45-degree field of view.
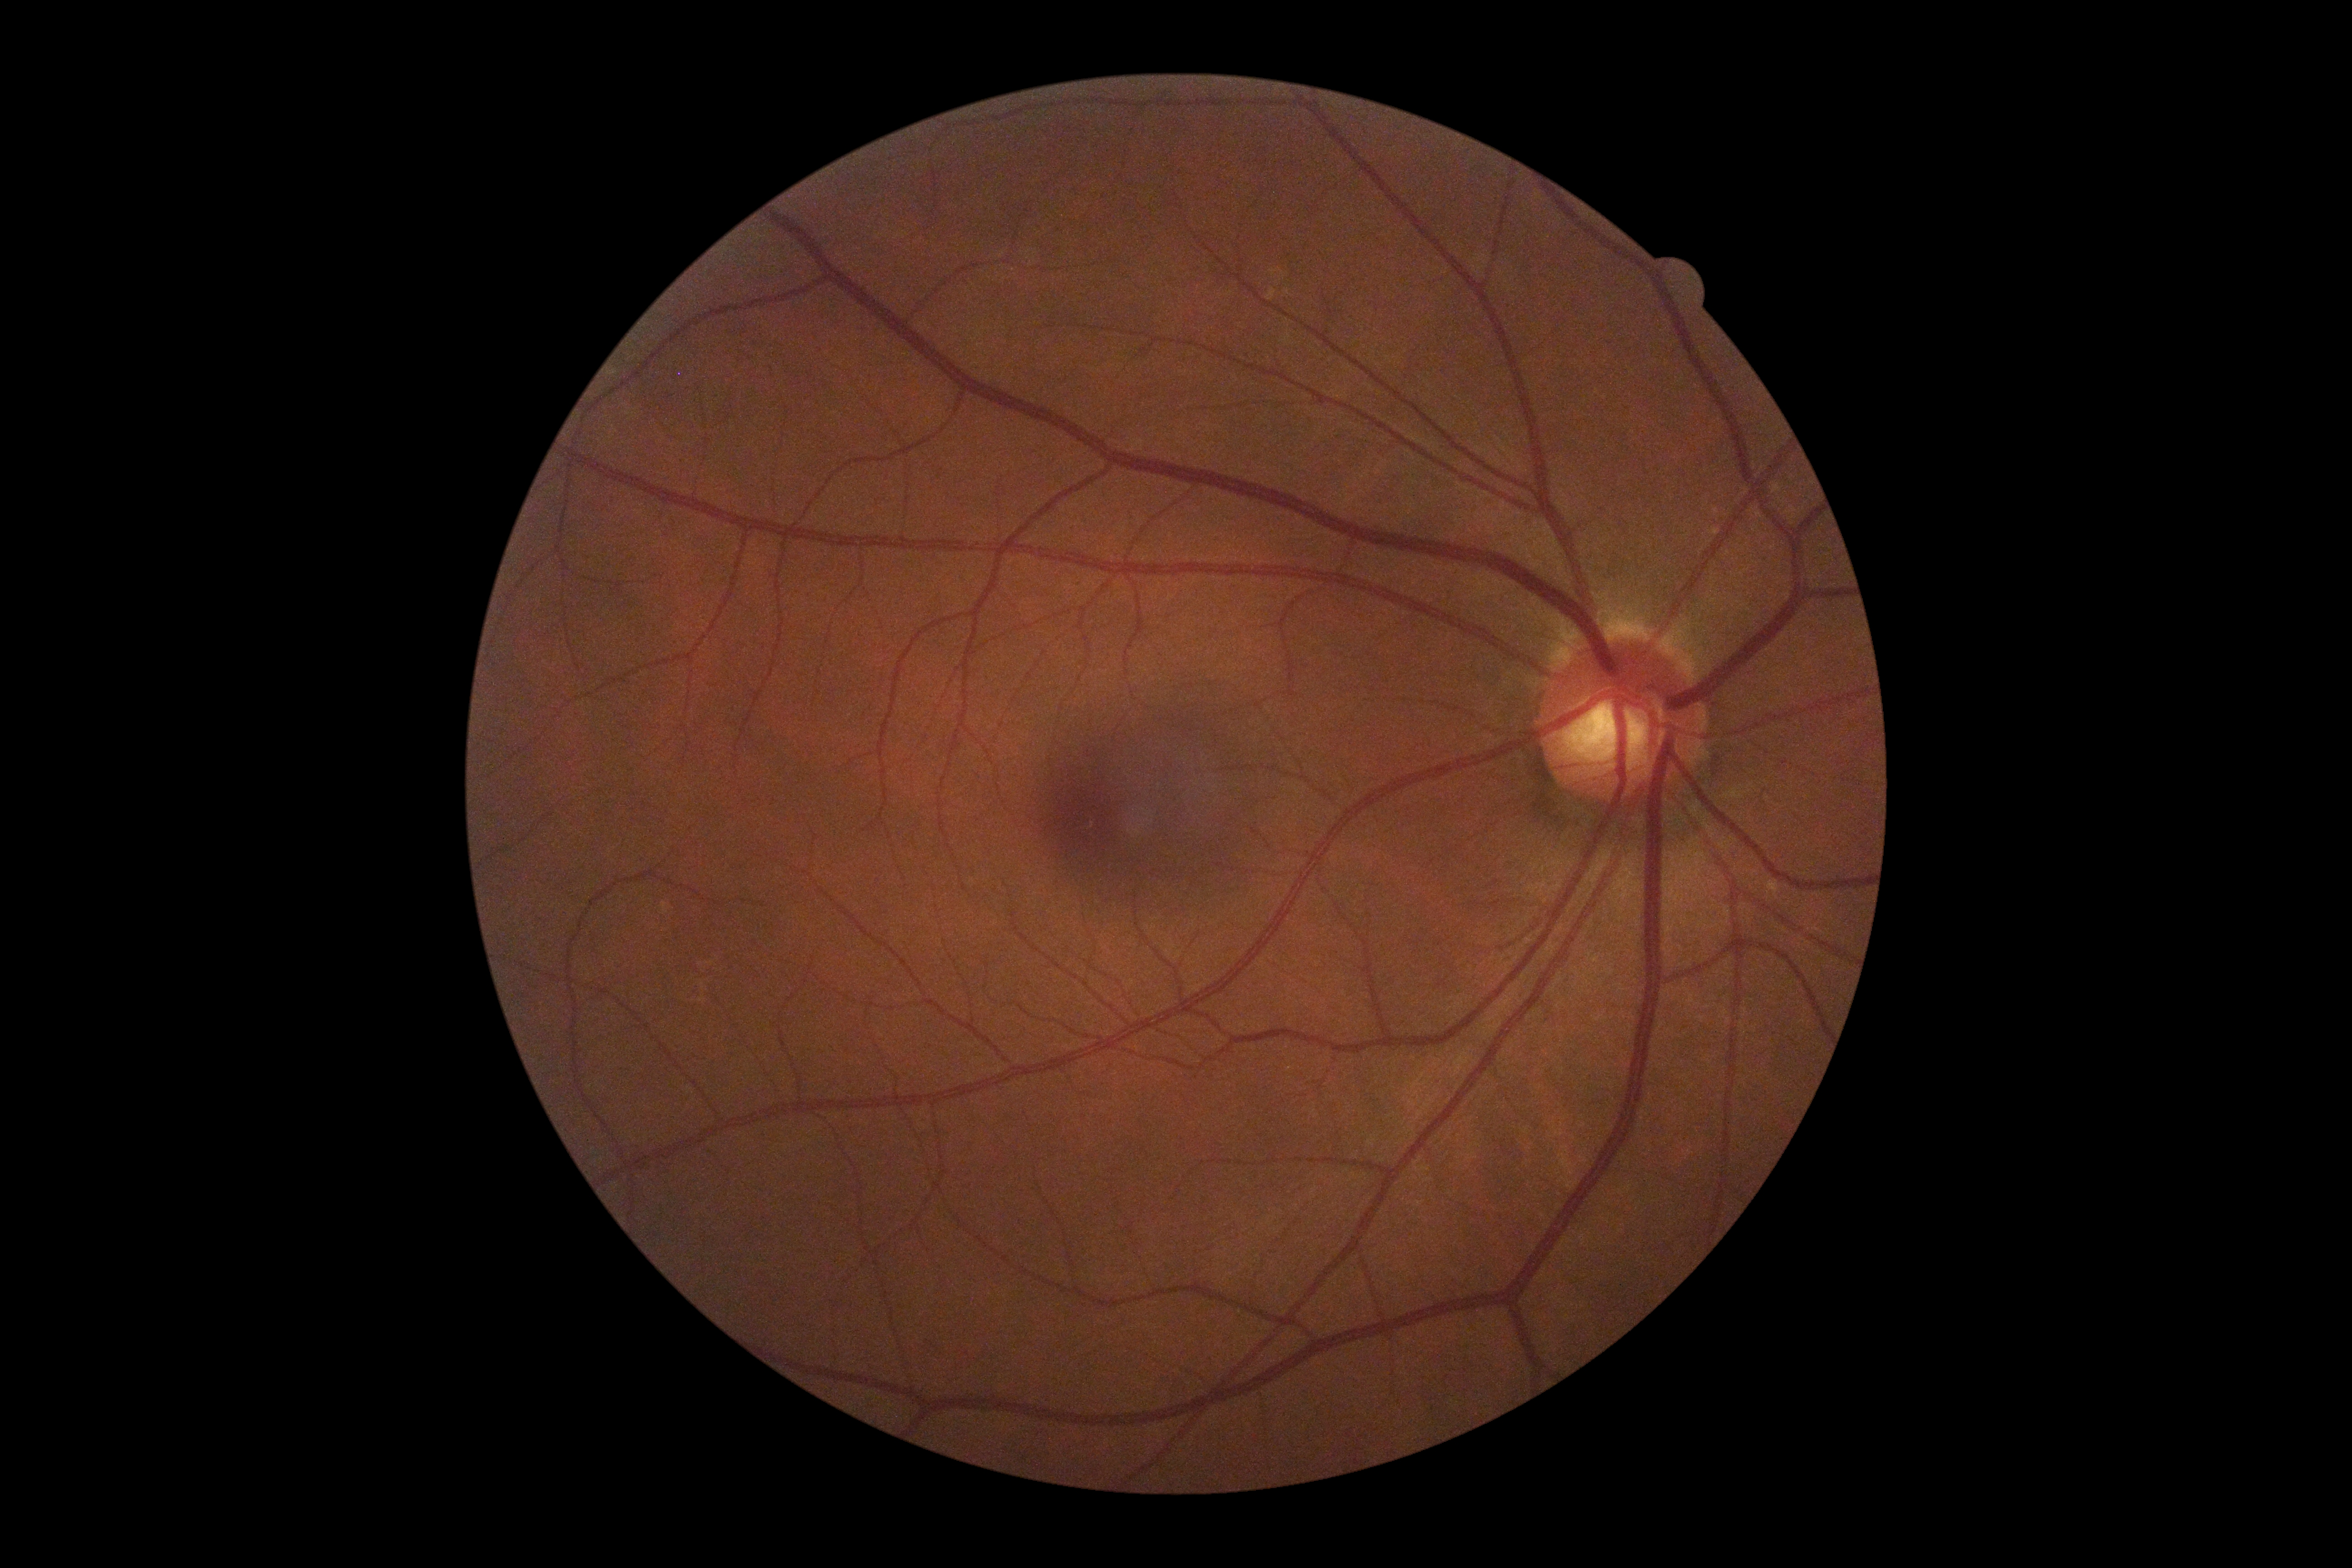 Findings:
* DR stage: grade 0 (no apparent retinopathy) — no visible signs of diabetic retinopathy